Modified Davis classification. No pharmacologic dilation.
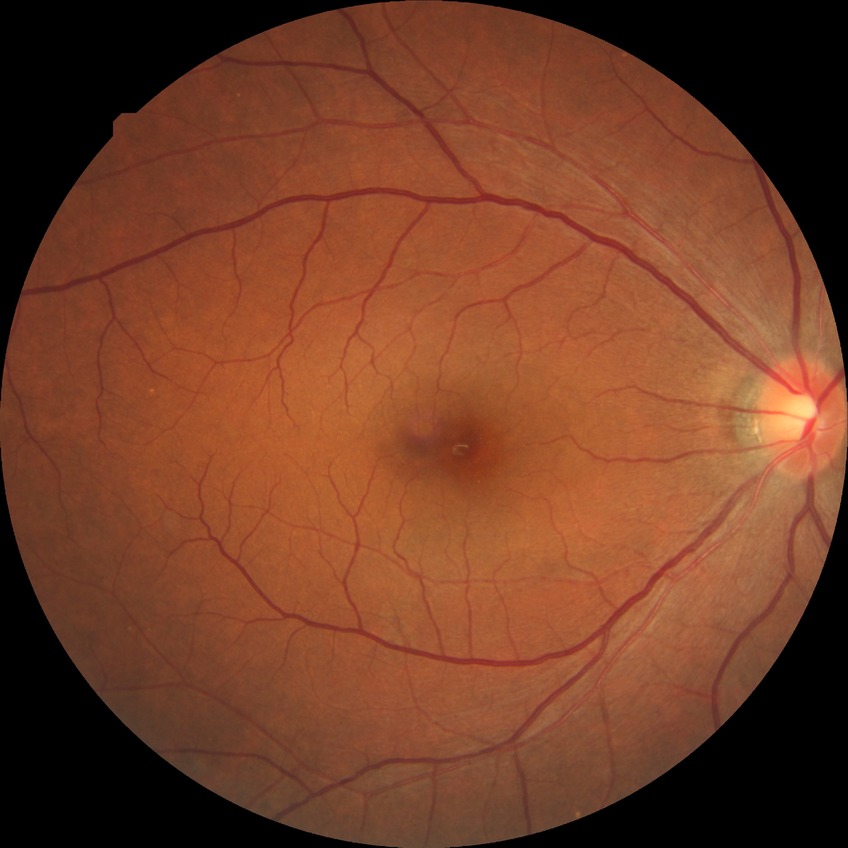

Diabetic retinopathy (DR) is NDR (no diabetic retinopathy).